Wide-field fundus image from infant ROP screening · 1240x1240px — 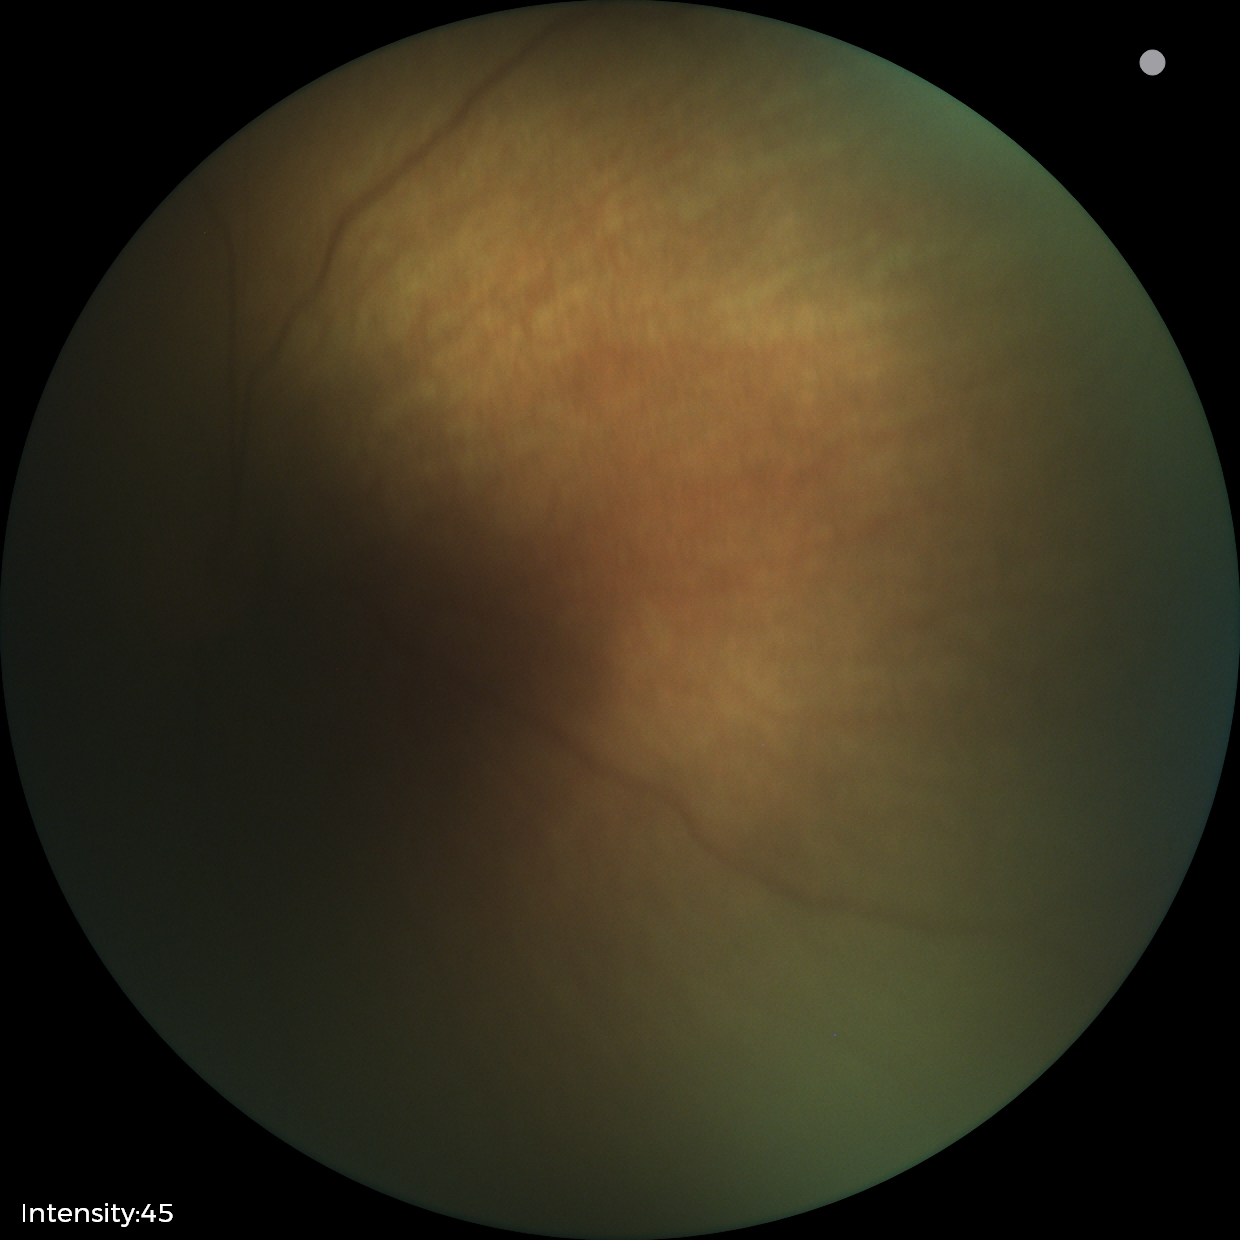

Screening examination with no abnormal retinal findings.